45° FOV; 848x848px; camera: NIDEK AFC-230.
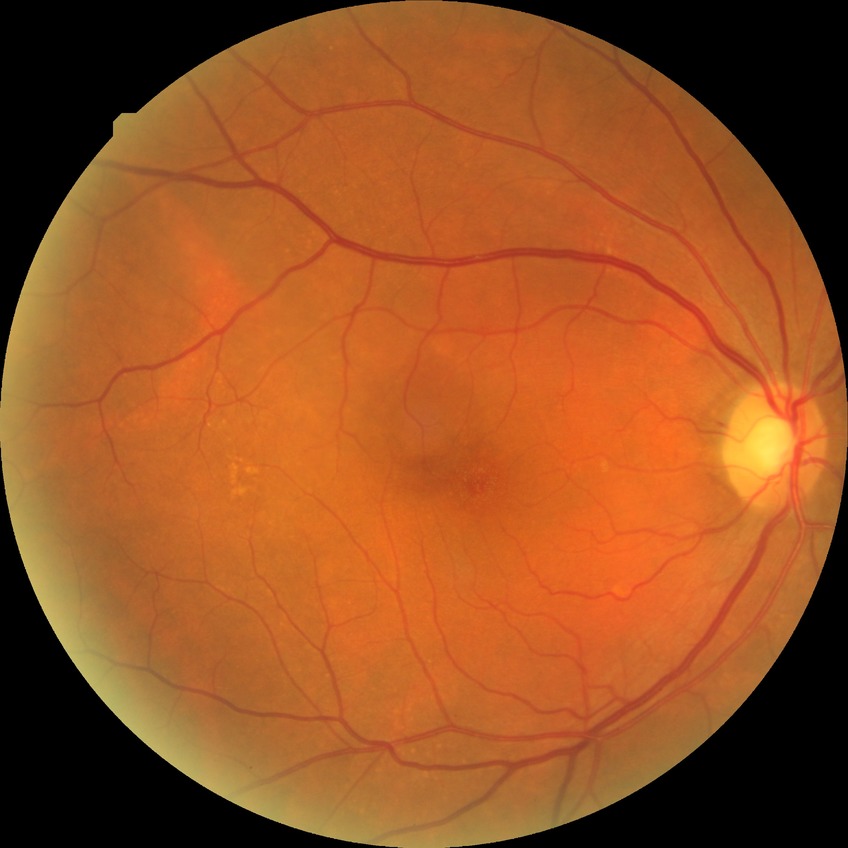
{
  "davis_grade": "no diabetic retinopathy (NDR)"
}